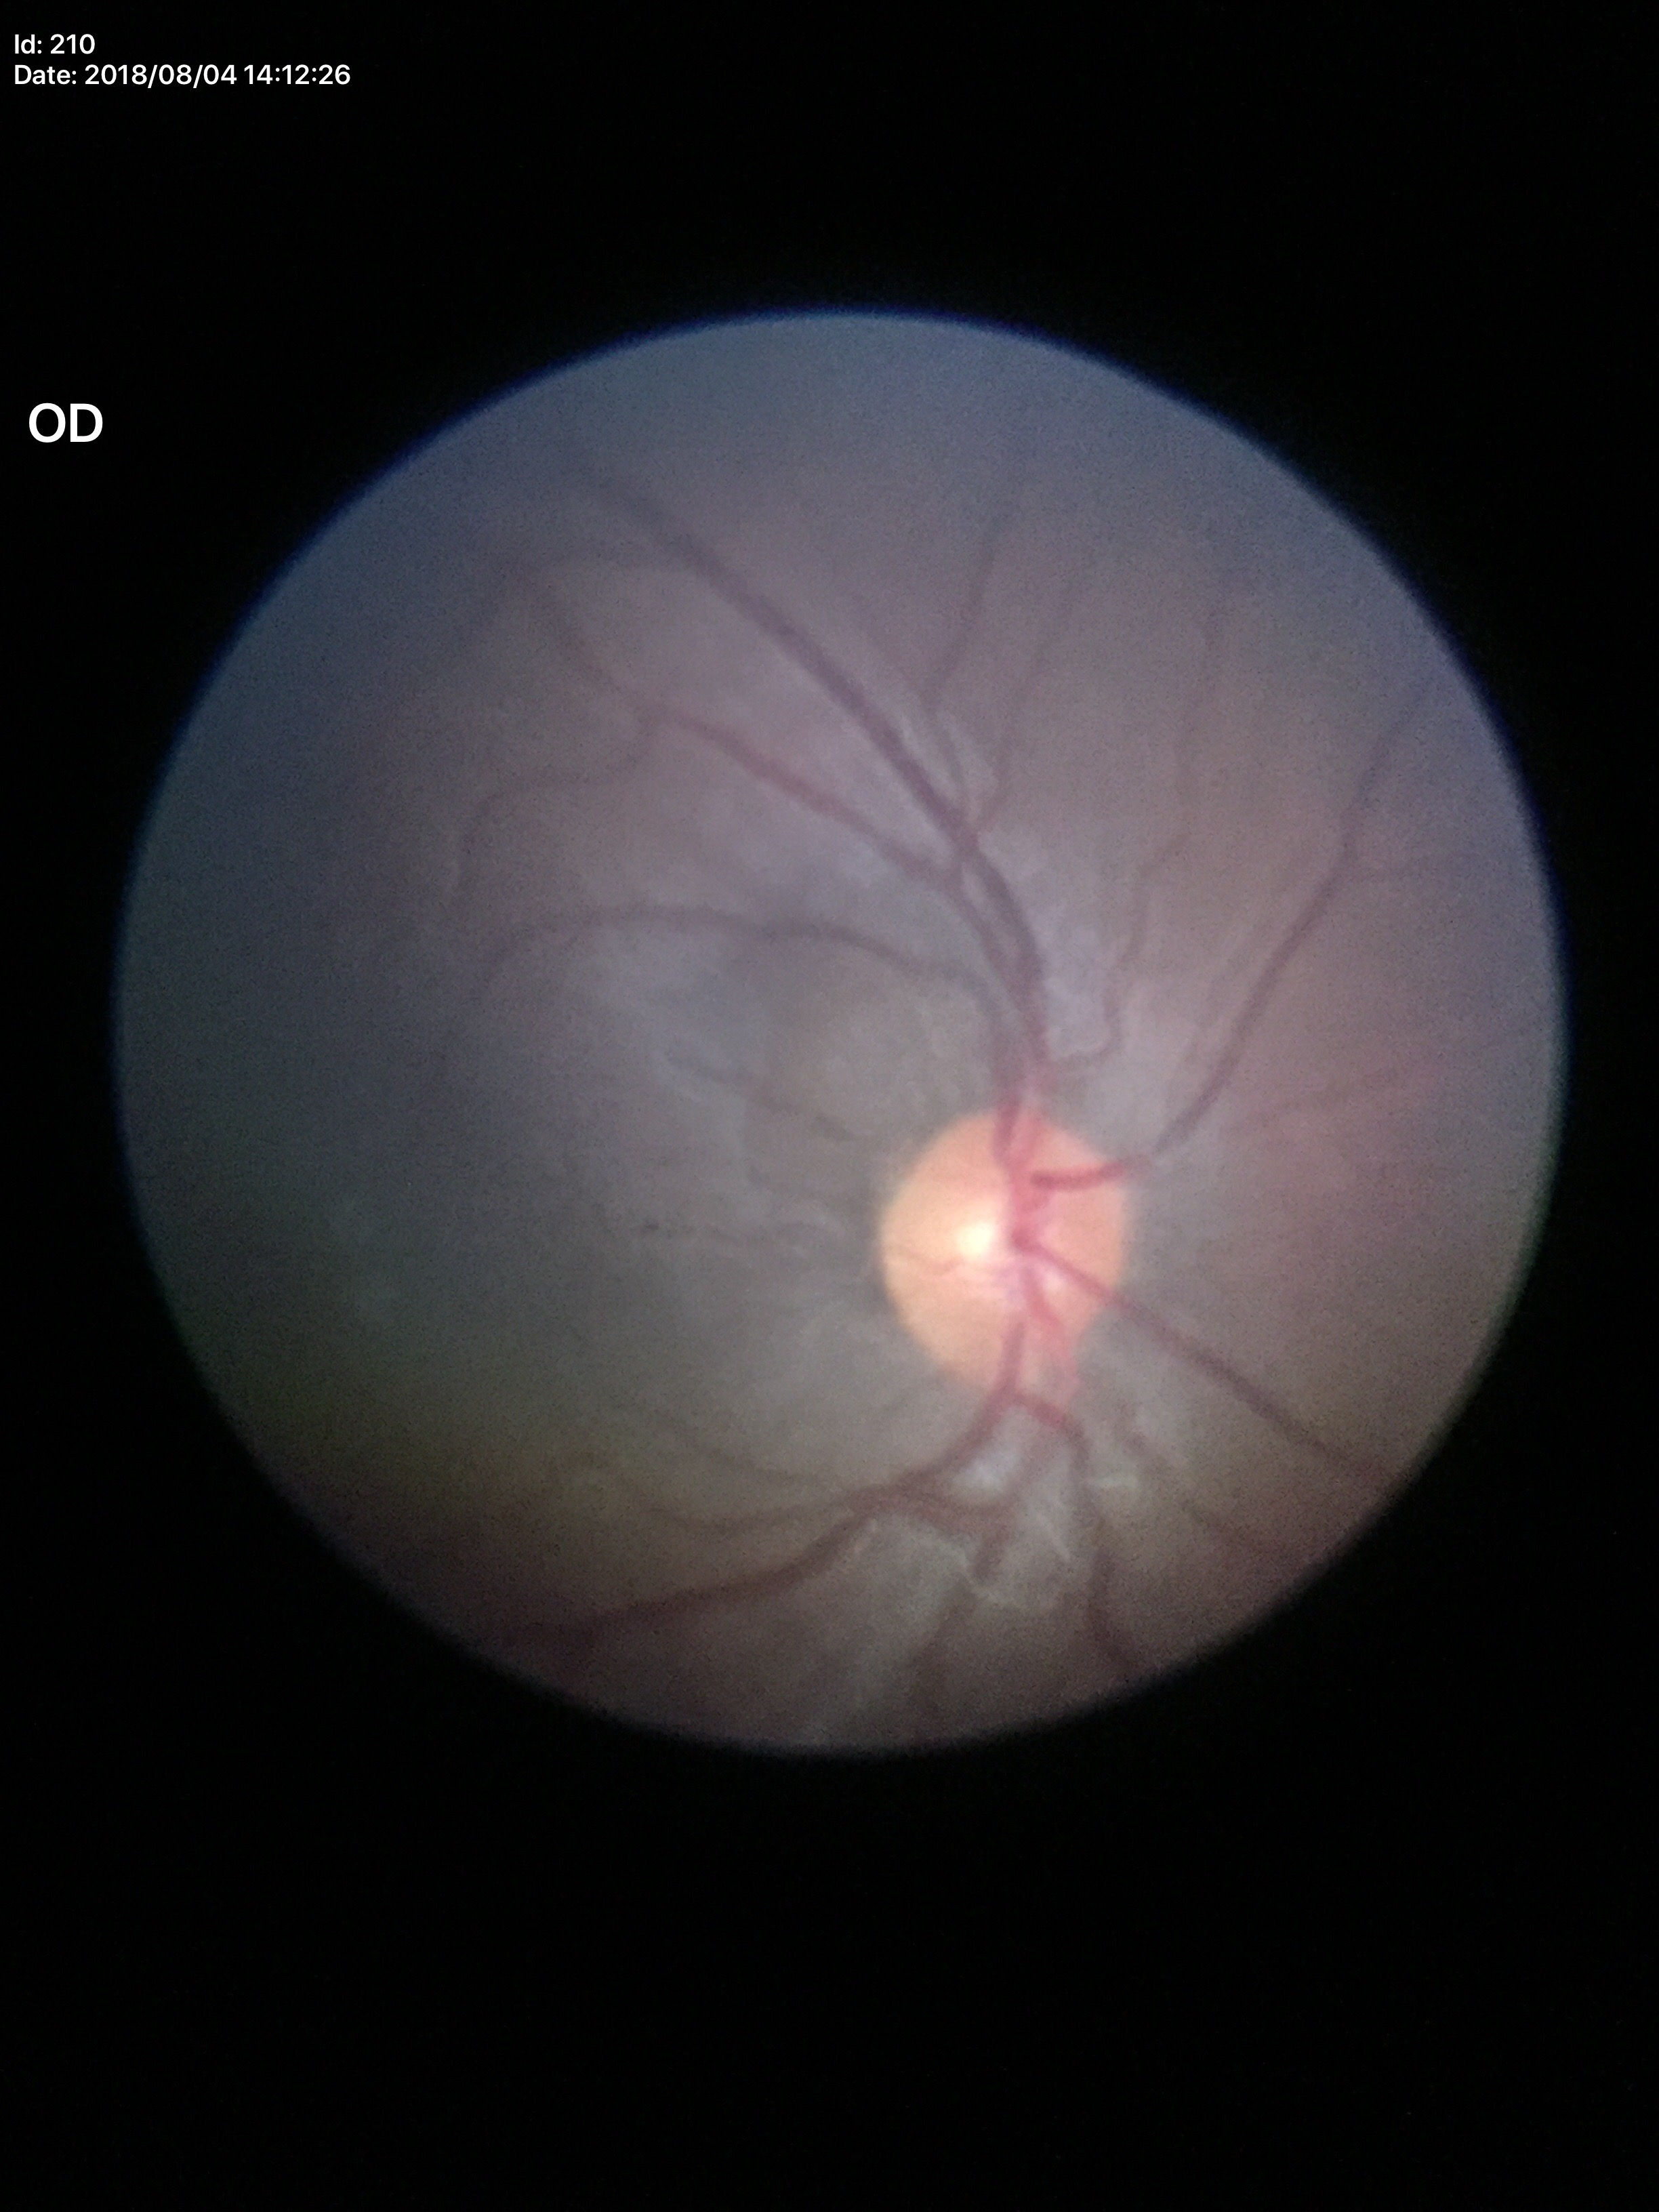

Glaucoma evaluation: no suspicious findings | vertical cup-to-disc ratio: 0.49